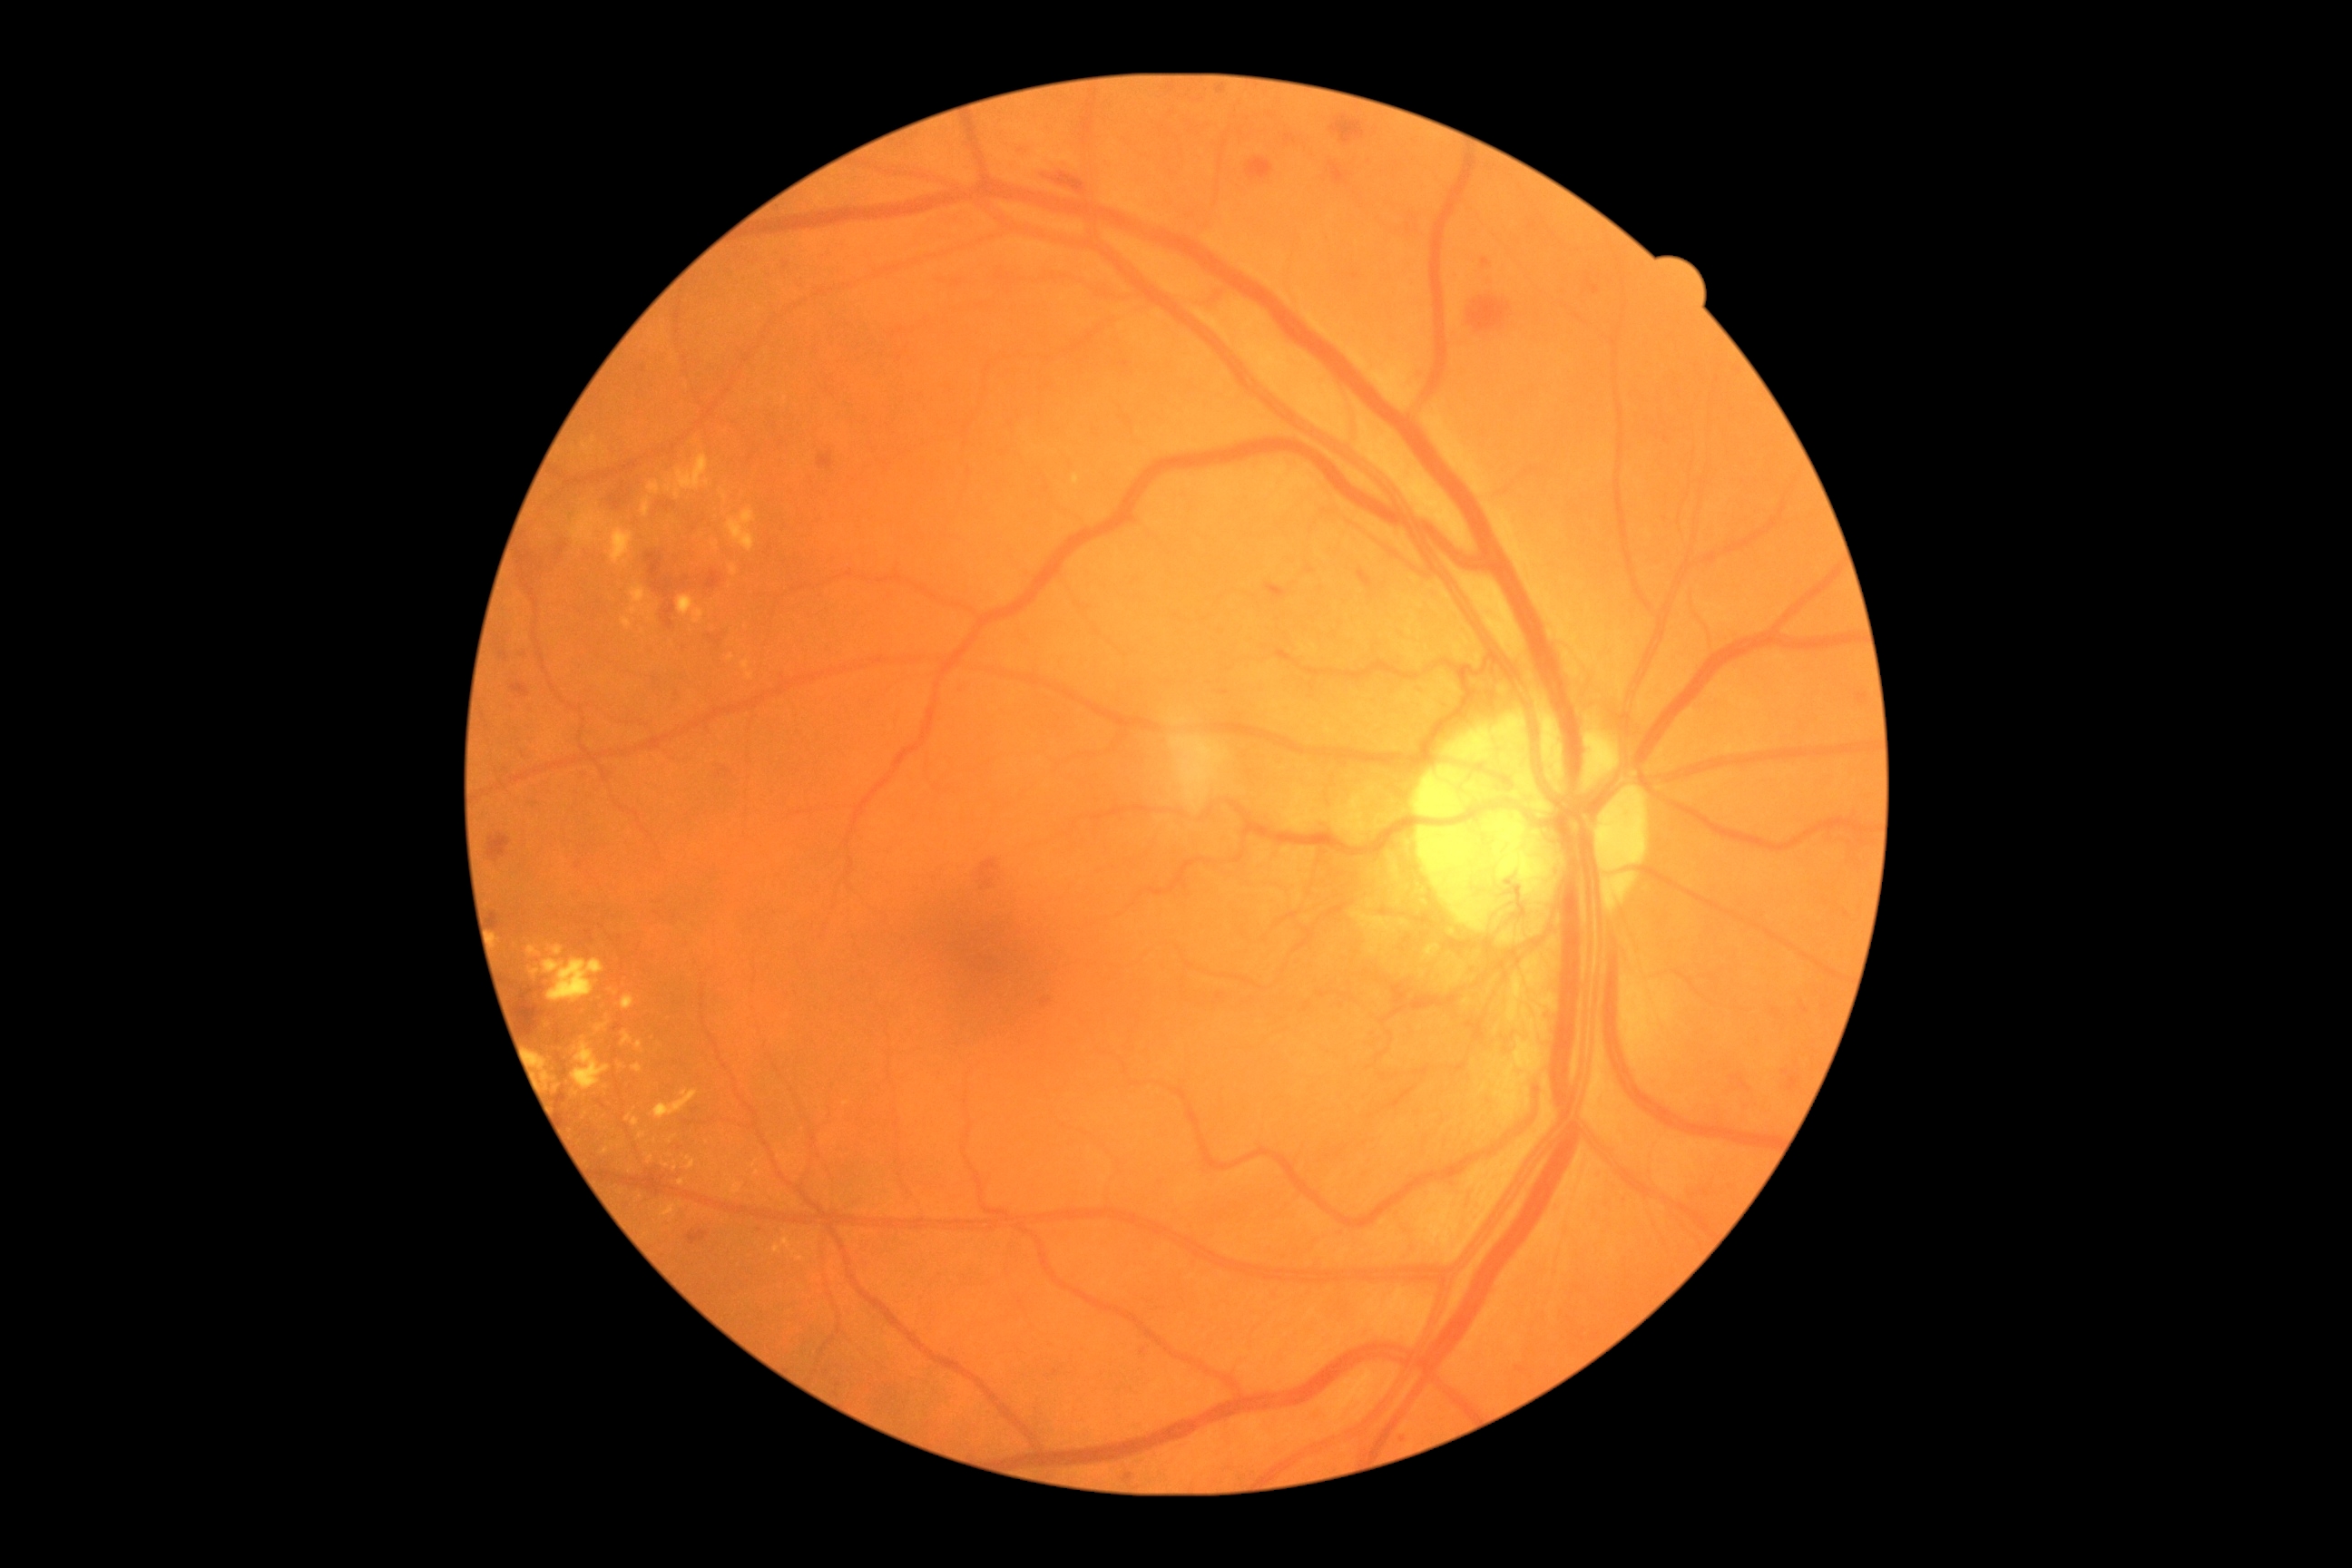 {"partial": true, "dr_grade": 4, "lesions": {"ex": [[571, 513, 602, 544], [638, 1133, 647, 1141], [663, 1164, 671, 1168], [642, 498, 651, 518], [622, 995, 636, 1012], [654, 1090, 698, 1119], [774, 1246, 781, 1255], [667, 485, 672, 493], [631, 585, 647, 605], [783, 1239, 792, 1250], [649, 482, 660, 495], [741, 662, 750, 671], [622, 618, 632, 629], [531, 970, 540, 977]], "ex_small_centers": [[675, 1169], [755, 1164], [731, 659], [794, 1253], [689, 1159]]}}